Wide-field fundus image from infant ROP screening · 1240x1240.
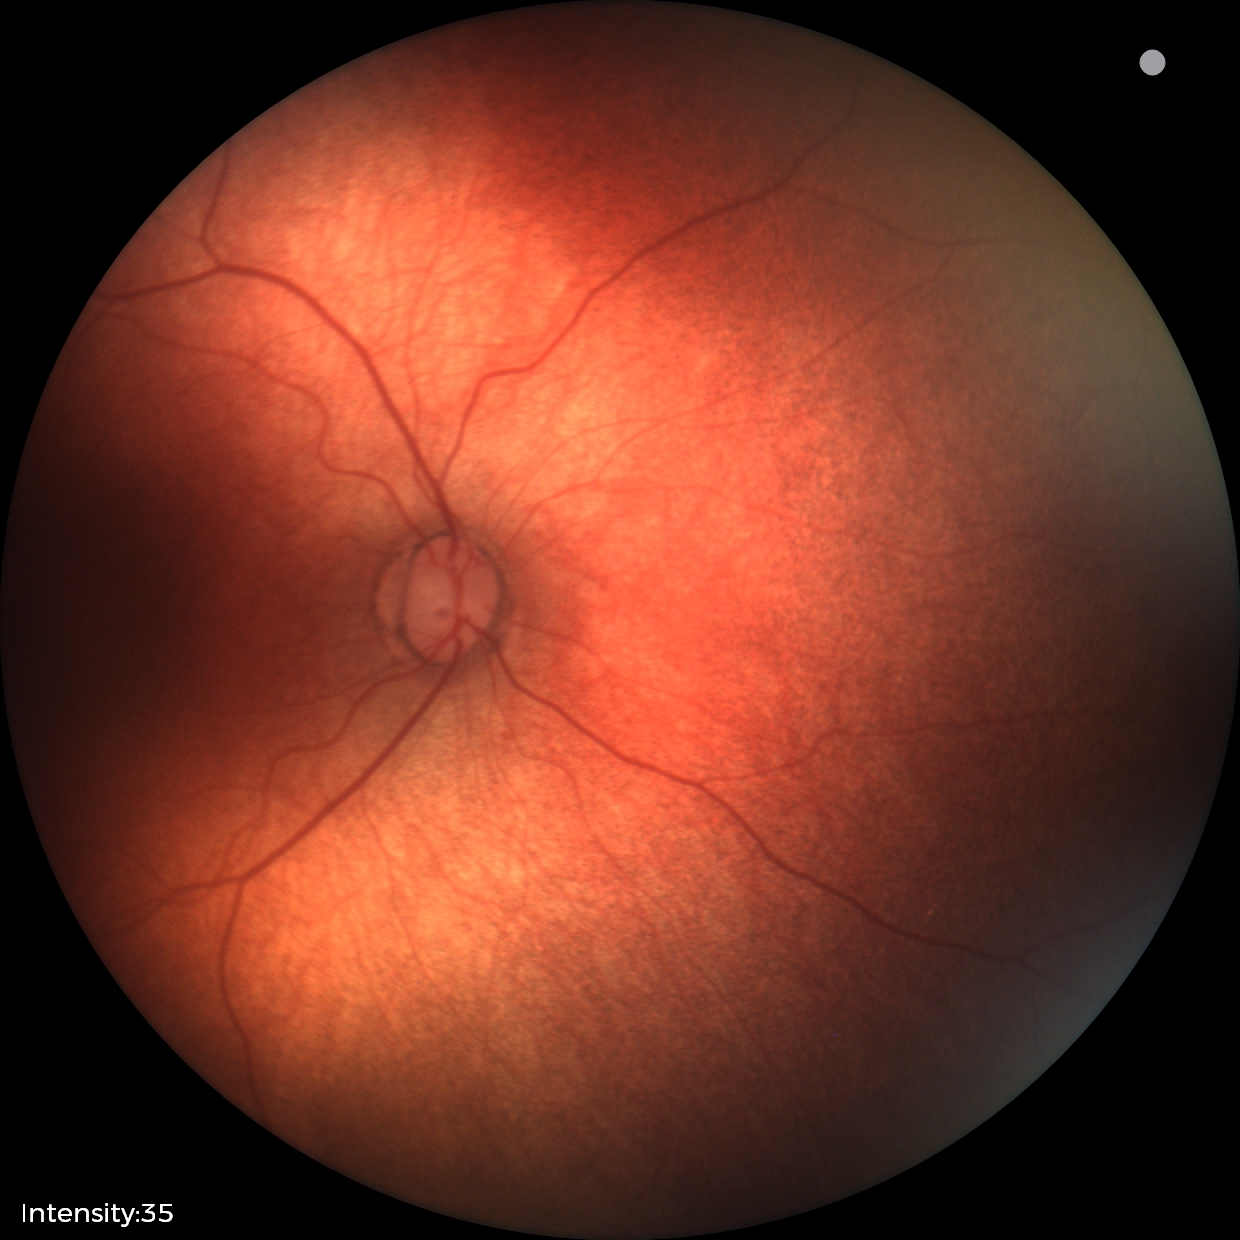
Screening: physiological finding.